Color fundus image, 2048 x 1536 pixels
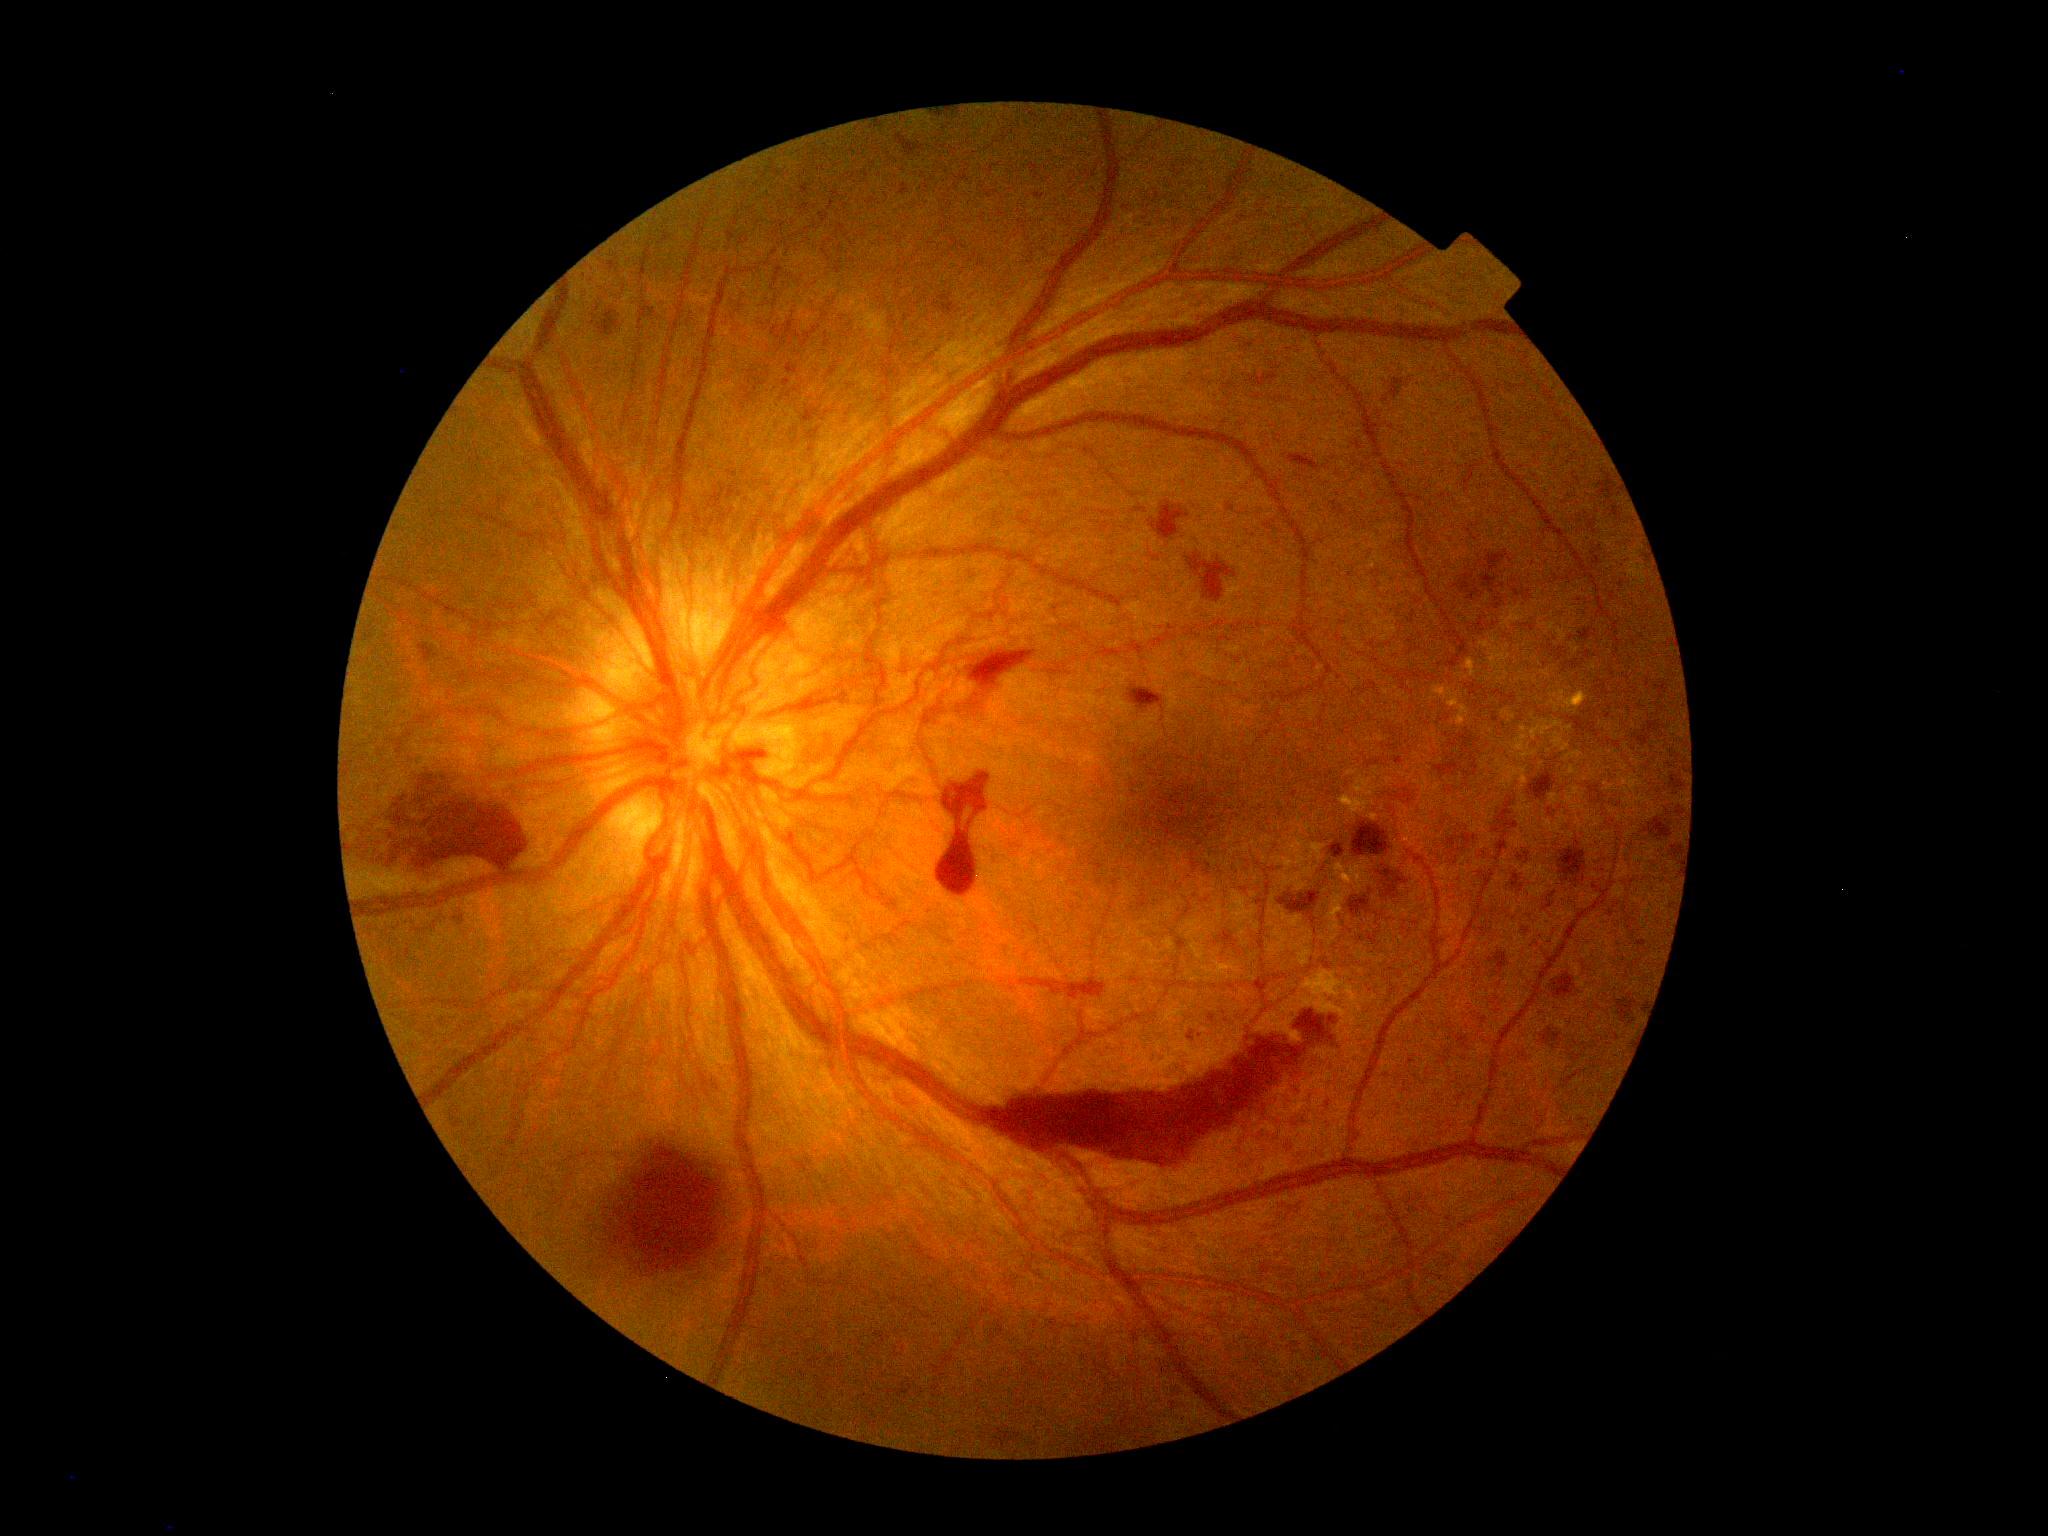
DR stage: grade 4 (PDR). DR class: proliferative diabetic retinopathy.